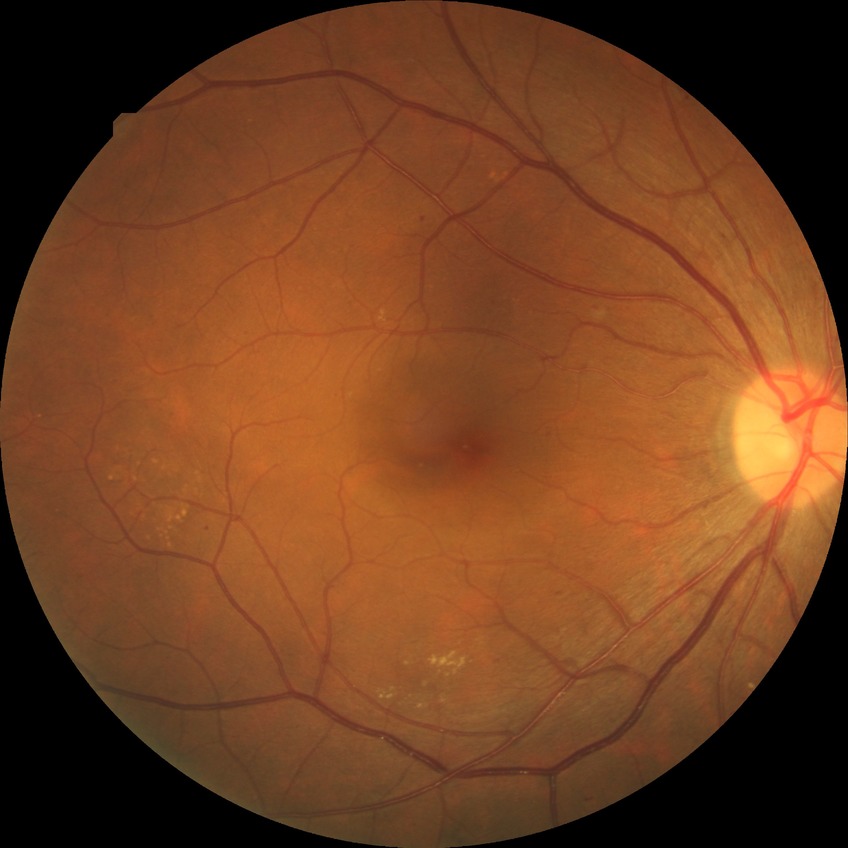
{
  "proliferative_class": "non-proliferative diabetic retinopathy",
  "davis_grade": "SDR"
}